Phoenix ICON wide-field infant fundus image · captured with the Phoenix ICON (100° field of view):
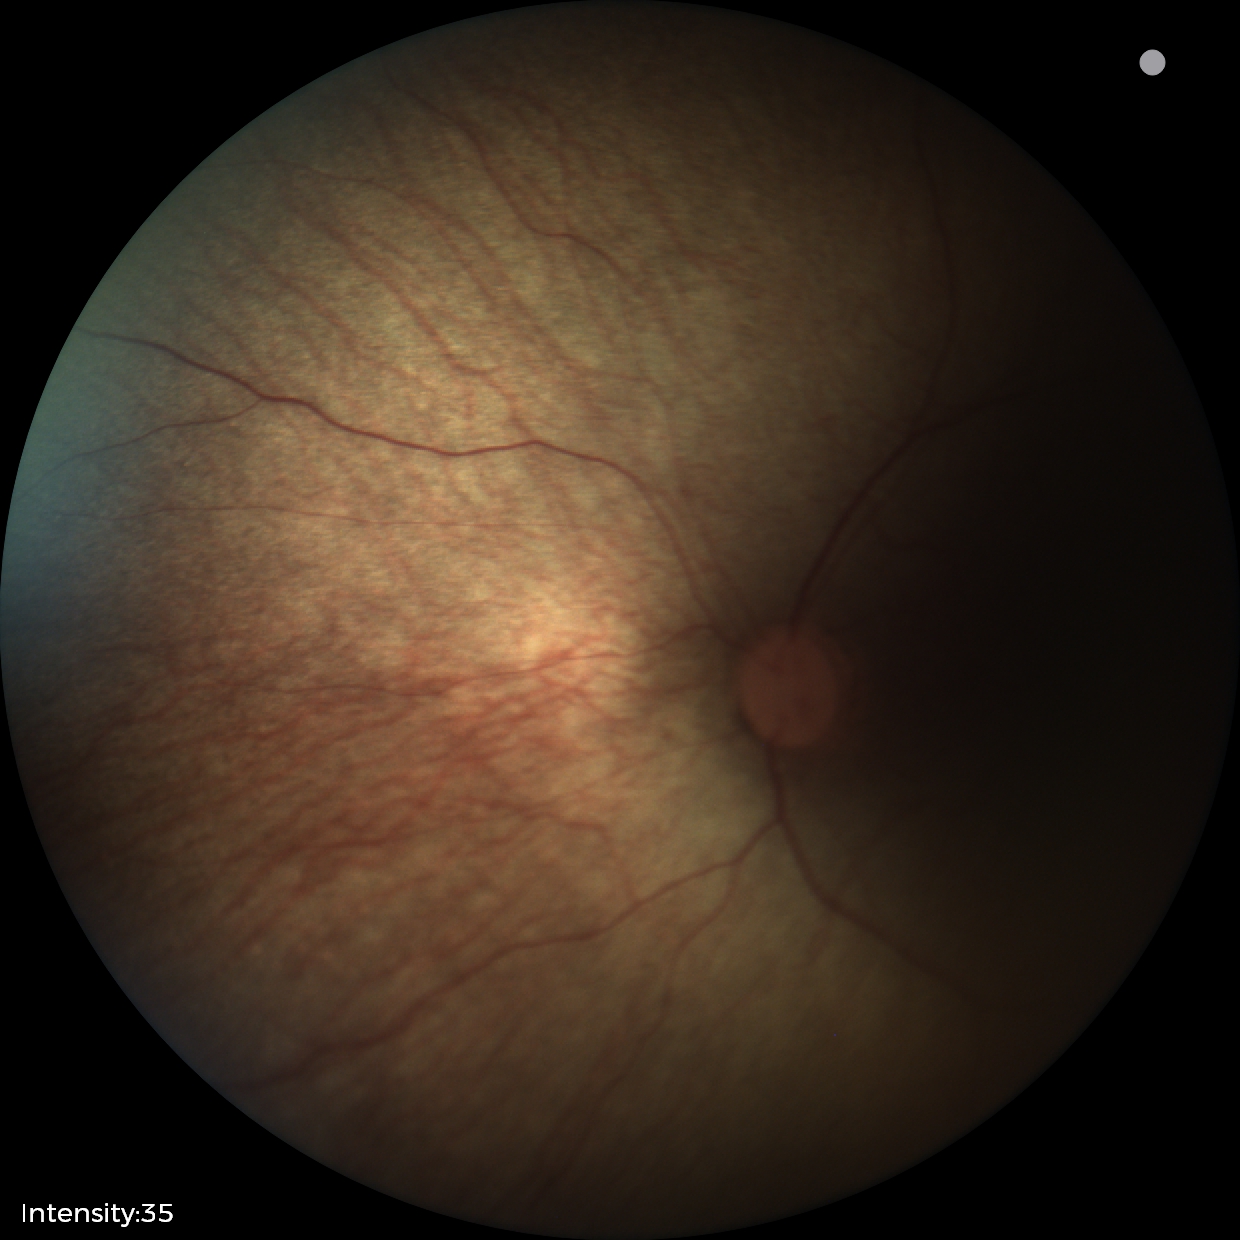 Screening examination with no abnormal retinal findings.